Color fundus photograph
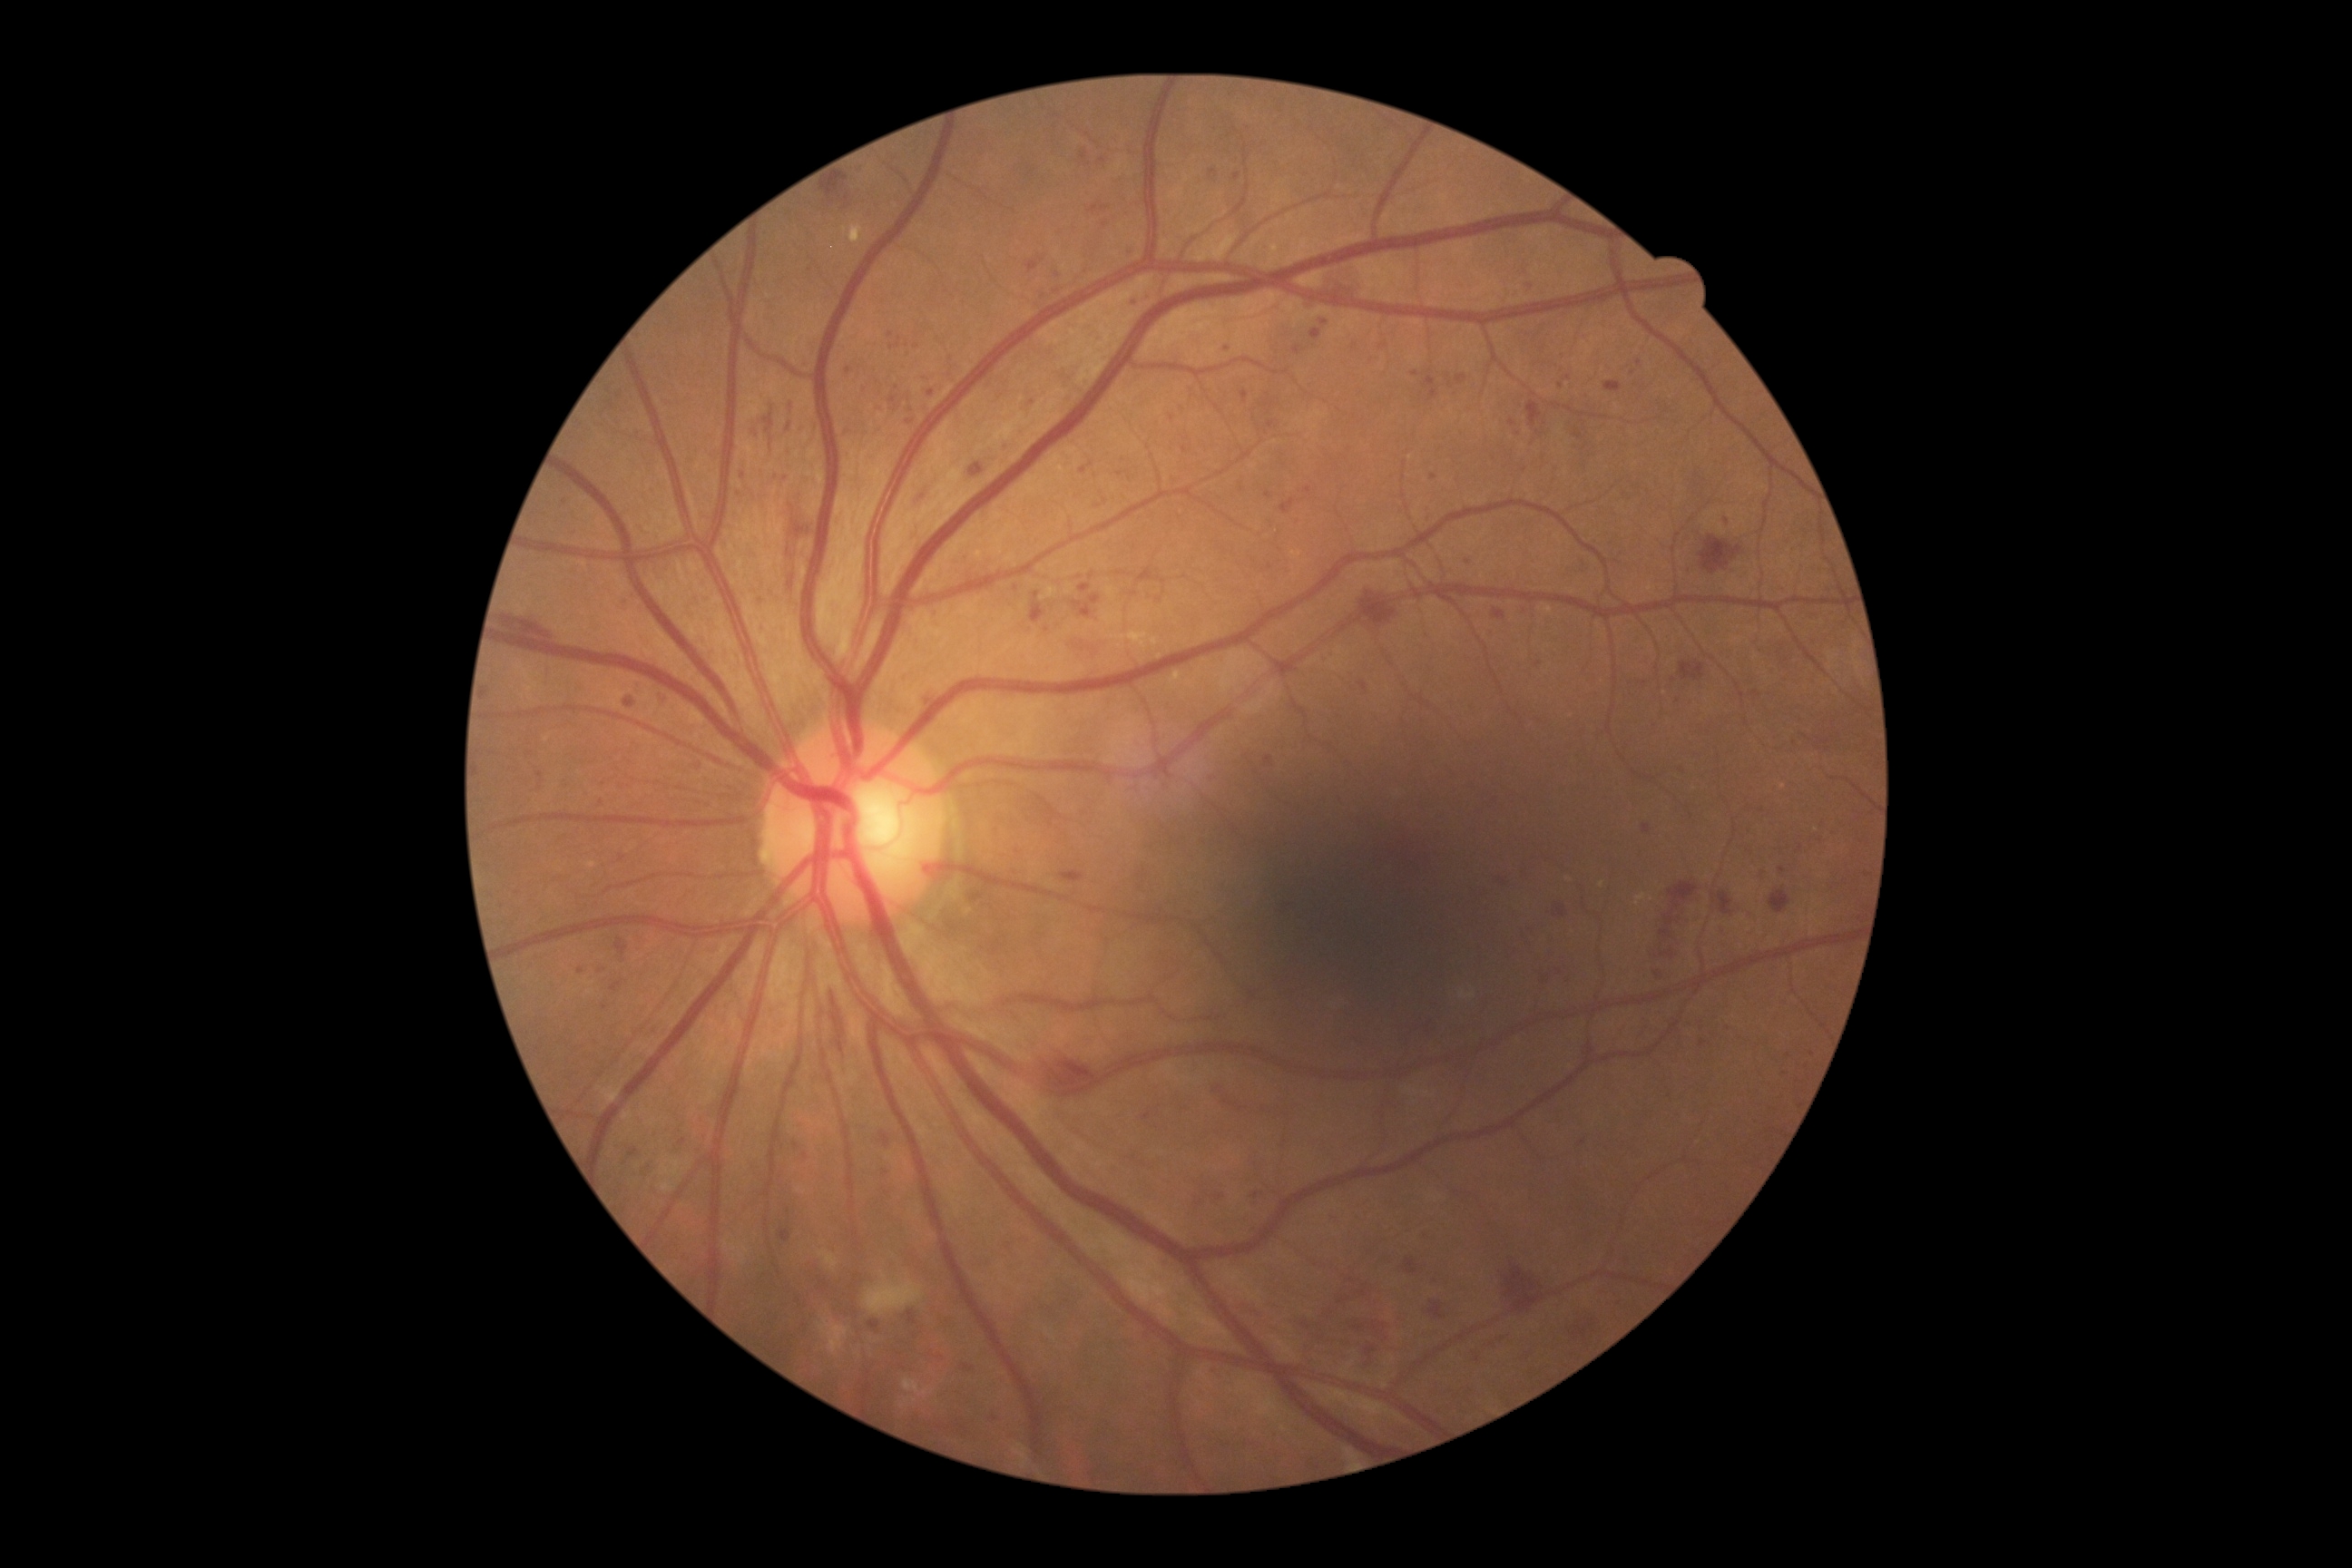
Diabetic retinopathy (DR) is grade 3 (severe NPDR); non-proliferative diabetic retinopathy
Representative lesions:
hemorrhages (HEs) (subset) = [left=1769, top=890, right=1792, bottom=914]; [left=789, top=513, right=807, bottom=573]; [left=1554, top=905, right=1565, bottom=917]; [left=1326, top=262, right=1366, bottom=295]; [left=1680, top=662, right=1705, bottom=681]; [left=1485, top=1335, right=1504, bottom=1348]; [left=1527, top=402, right=1542, bottom=427]; [left=1061, top=872, right=1084, bottom=883]; [left=1656, top=872, right=1700, bottom=979]; [left=1700, top=536, right=1743, bottom=574]; [left=1605, top=382, right=1622, bottom=393]; [left=1500, top=1255, right=1542, bottom=1298]
soft exudates (SEs) = [left=818, top=1250, right=839, bottom=1271]; [left=1014, top=1444, right=1030, bottom=1465]; [left=1344, top=1447, right=1360, bottom=1460]; [left=903, top=1378, right=936, bottom=1398]; [left=899, top=1398, right=917, bottom=1409]; [left=865, top=1271, right=925, bottom=1315]; [left=818, top=1320, right=848, bottom=1355]
microaneurysms (MAs) (subset) = [left=881, top=1133, right=890, bottom=1148]; [left=734, top=491, right=747, bottom=498]; [left=1235, top=173, right=1242, bottom=181]; [left=1090, top=206, right=1110, bottom=215]; [left=1529, top=280, right=1536, bottom=291]; [left=1360, top=681, right=1367, bottom=691]; [left=1032, top=591, right=1046, bottom=623]; [left=1578, top=1328, right=1589, bottom=1338]; [left=928, top=391, right=936, bottom=397]; [left=1146, top=291, right=1152, bottom=300]
Small MAs near pt(1433, 477); pt(1345, 1300); pt(787, 479); pt(1428, 523); pt(541, 775); pt(1640, 363); pt(848, 371); pt(1569, 378); pt(1172, 419)
hard exudates (EXs) = [left=1170, top=672, right=1184, bottom=691]; [left=1636, top=894, right=1647, bottom=906]; [left=1110, top=631, right=1150, bottom=651]; [left=1152, top=638, right=1159, bottom=647]; [left=975, top=549, right=985, bottom=560]; [left=587, top=861, right=596, bottom=868]; [left=850, top=224, right=865, bottom=244]; [left=1041, top=587, right=1059, bottom=600]; [left=598, top=1086, right=622, bottom=1106]
Small EXs near pt(1602, 885); pt(1570, 879); pt(1652, 899); pt(1159, 657); pt(1190, 684)